Acquired on the Phoenix ICON; infant wide-field fundus photograph.
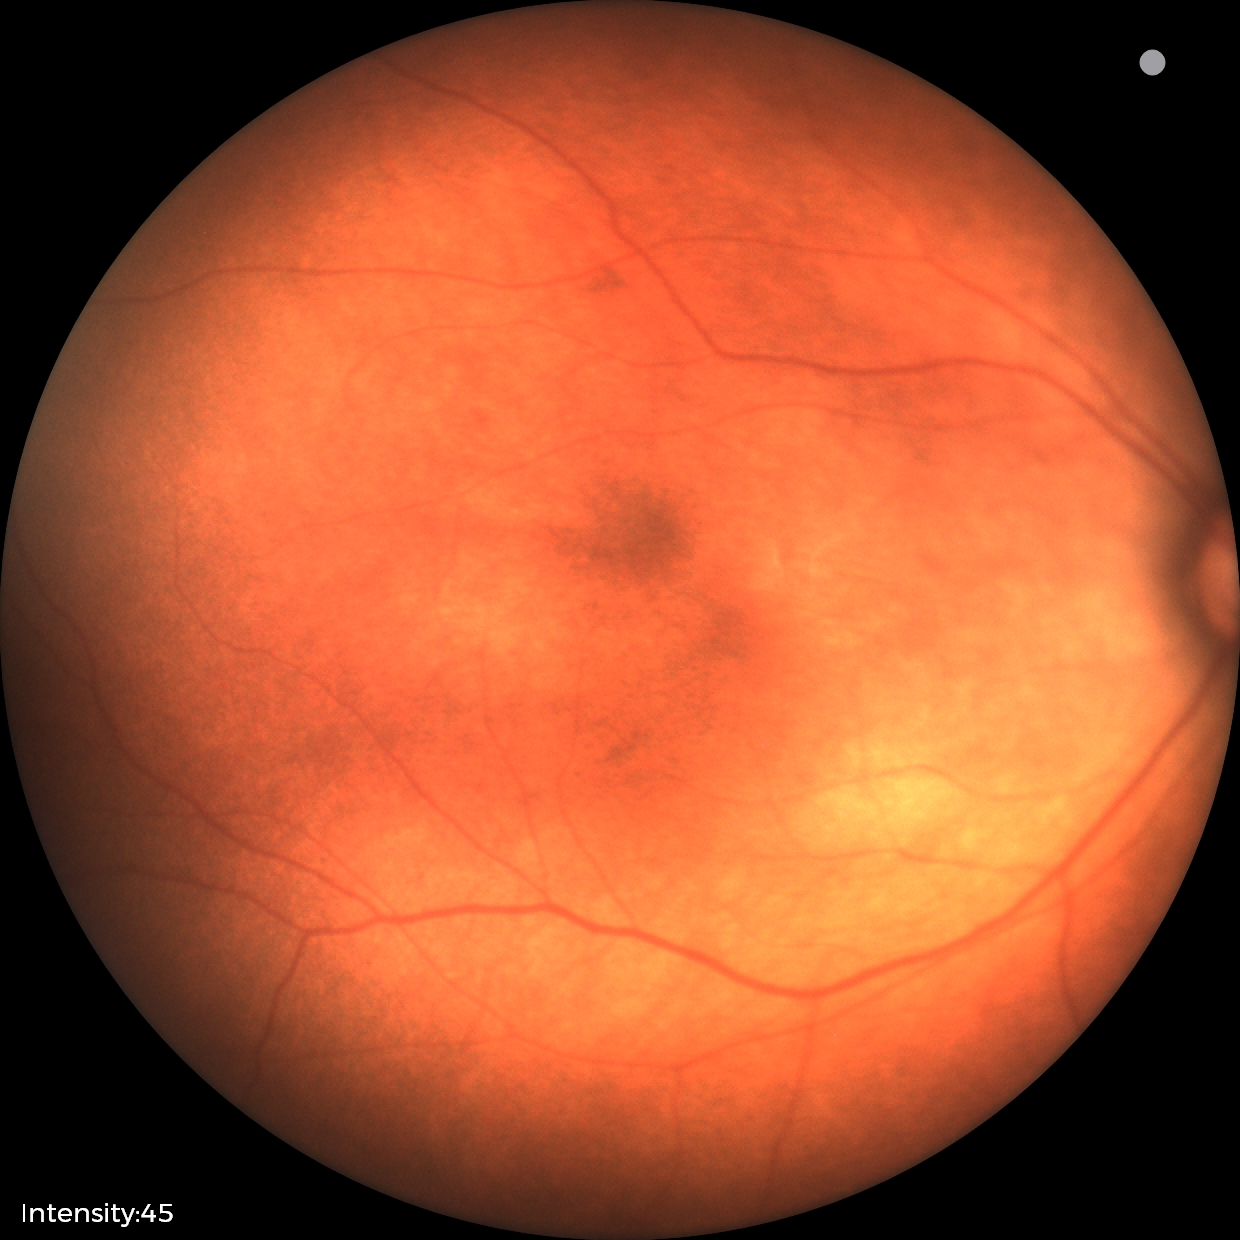
Screening examination consistent with retinopathy of prematurity stage 2. Without plus disease.